Infant wide-field fundus photograph — 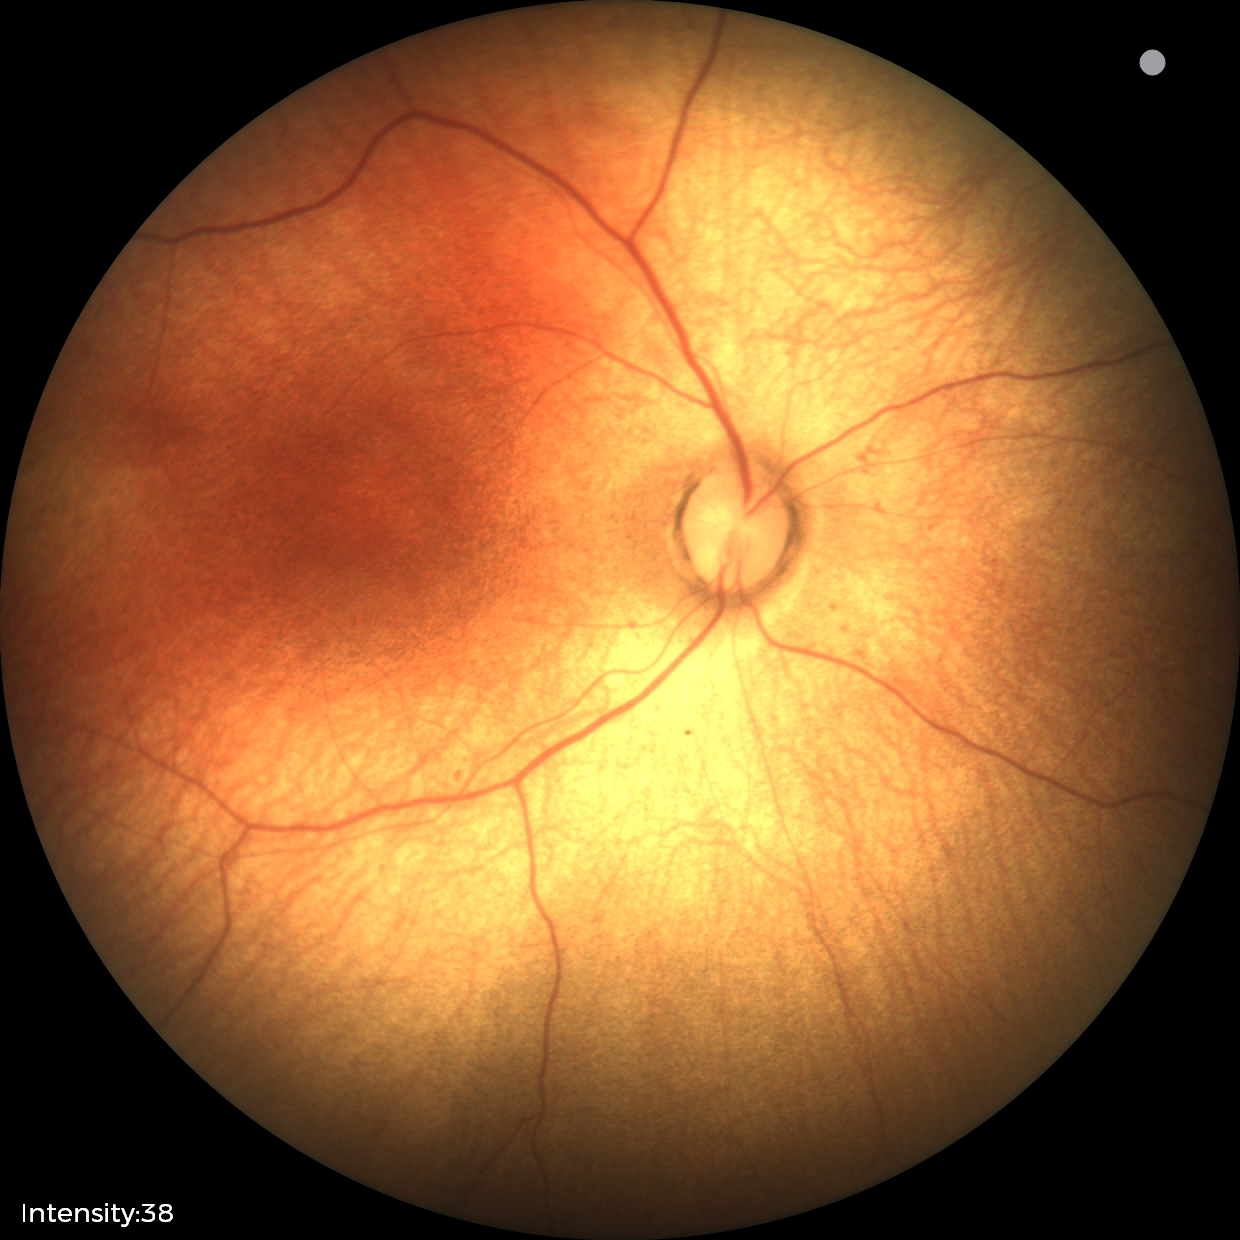
Screening diagnosis: normal.